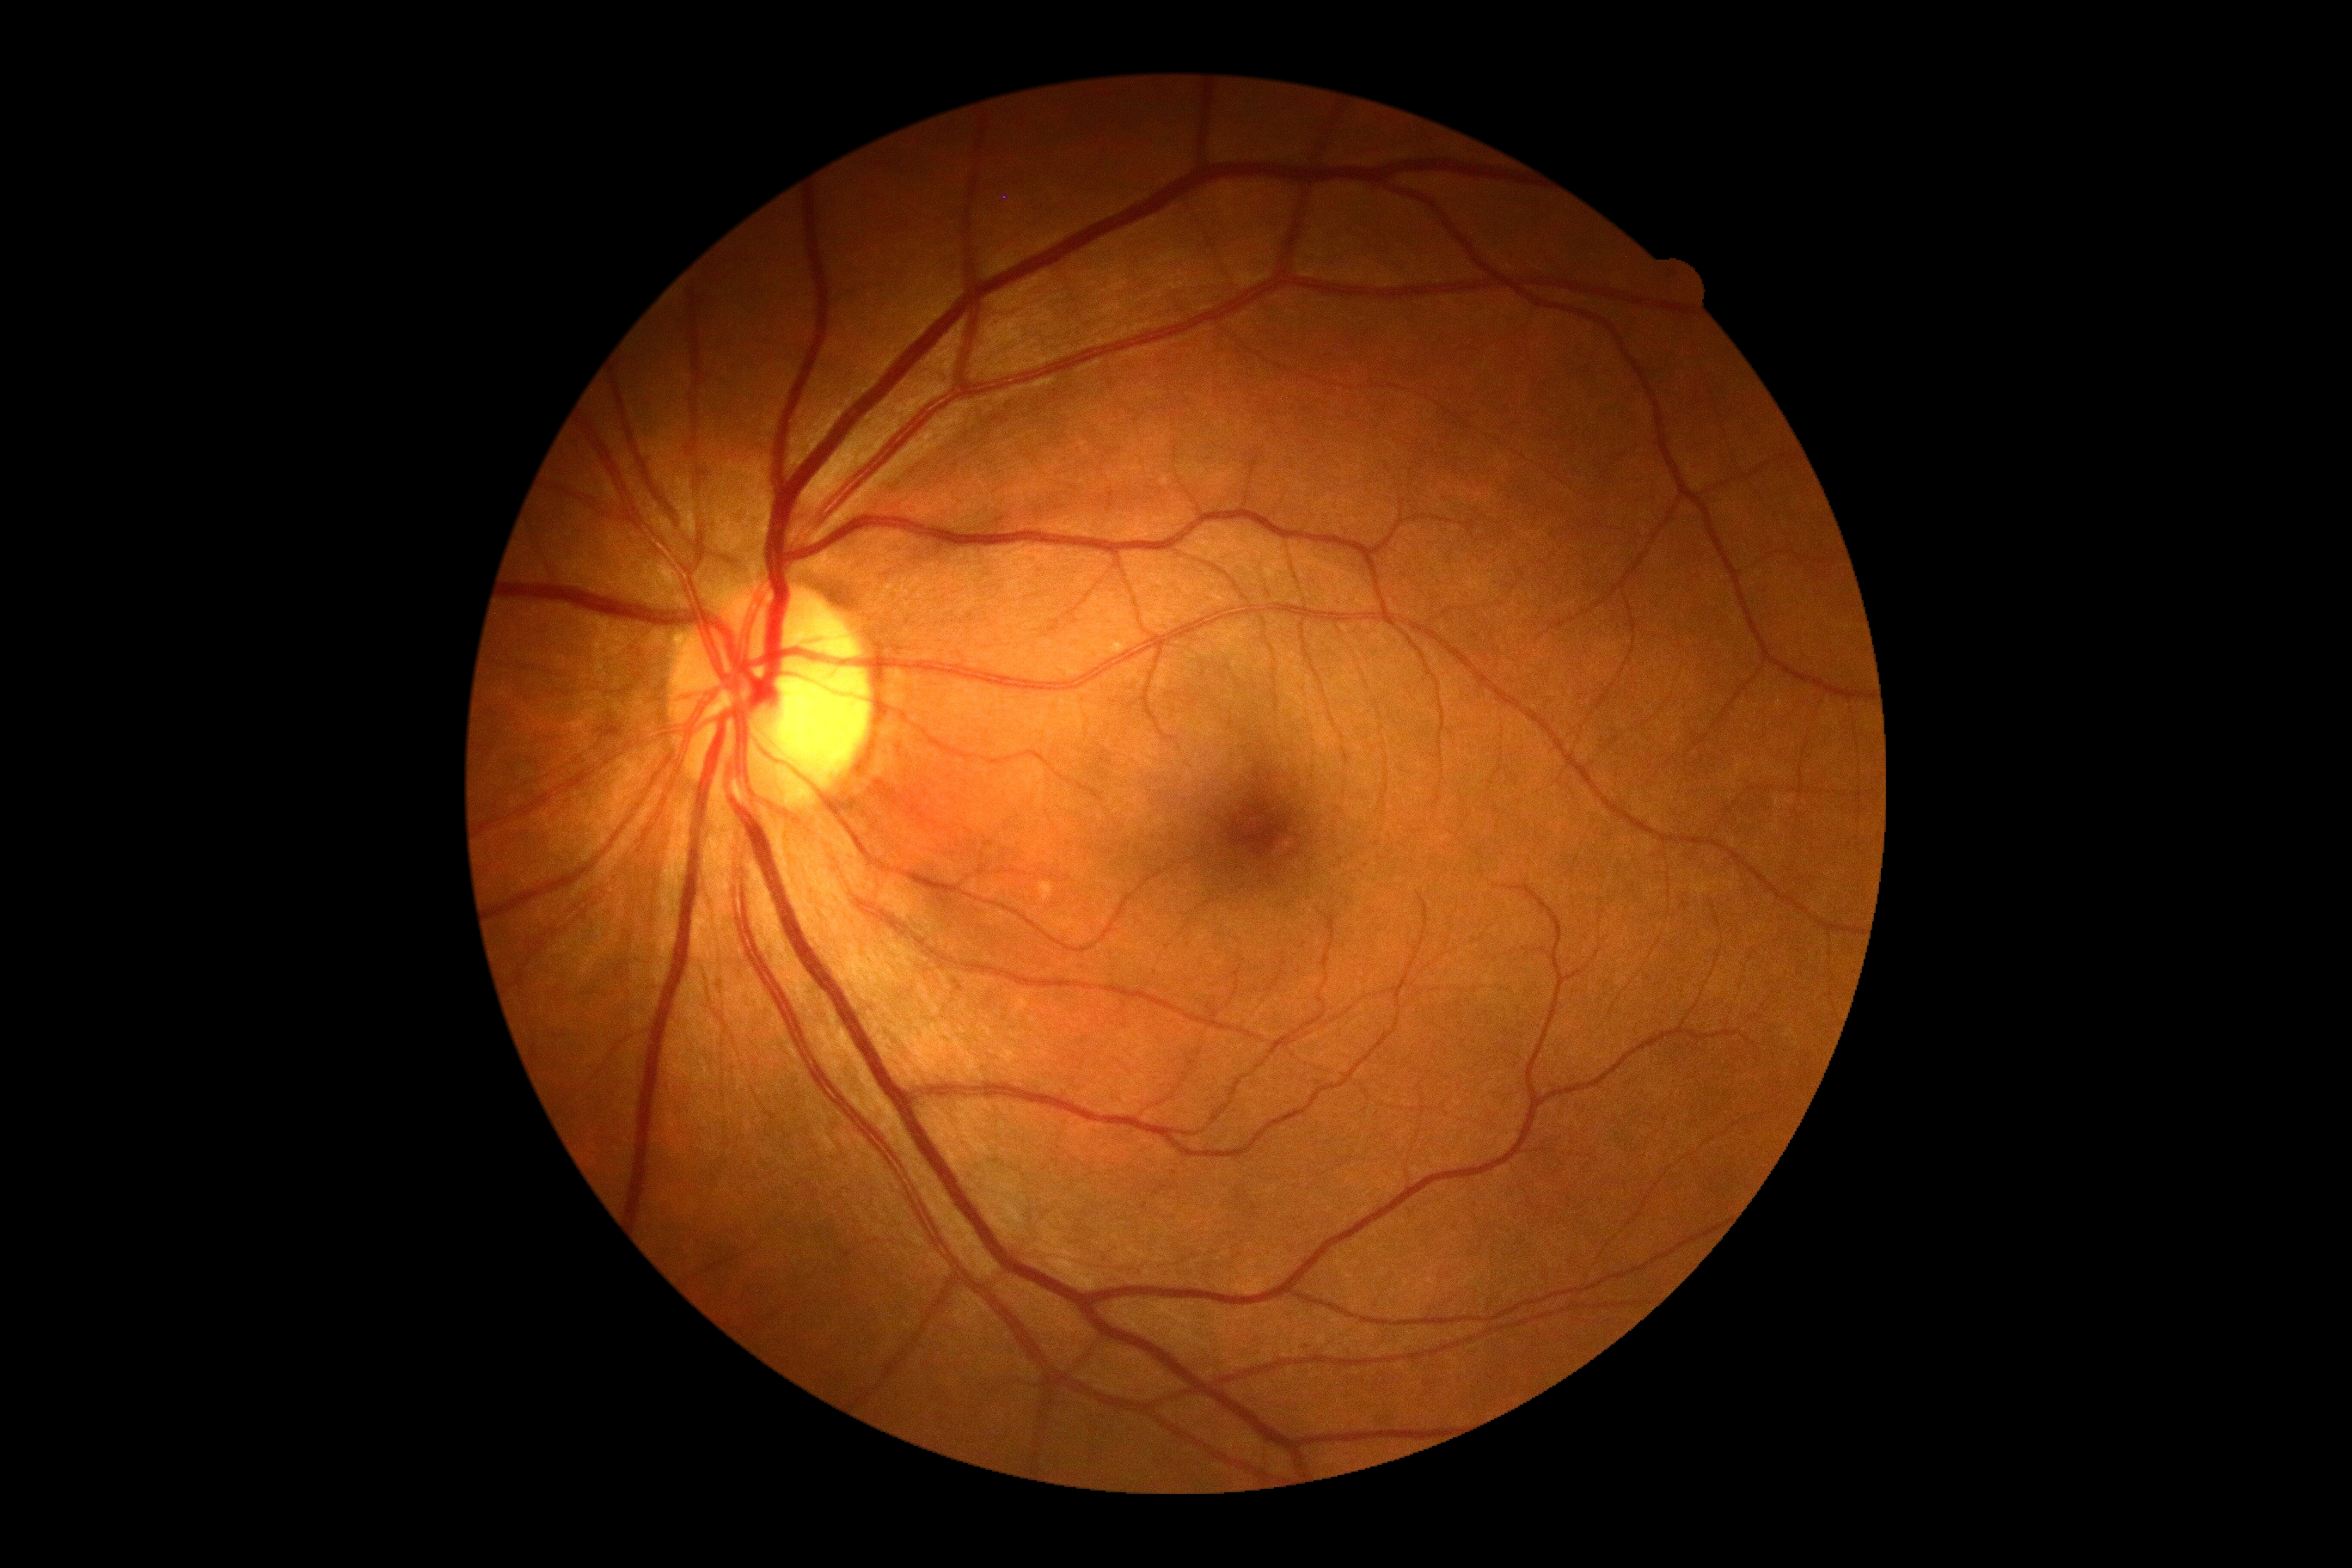 Diabetic retinopathy grade is 0 (no apparent retinopathy).